1659x2212 · Remidio FOP fundus camera · retinal fundus photograph
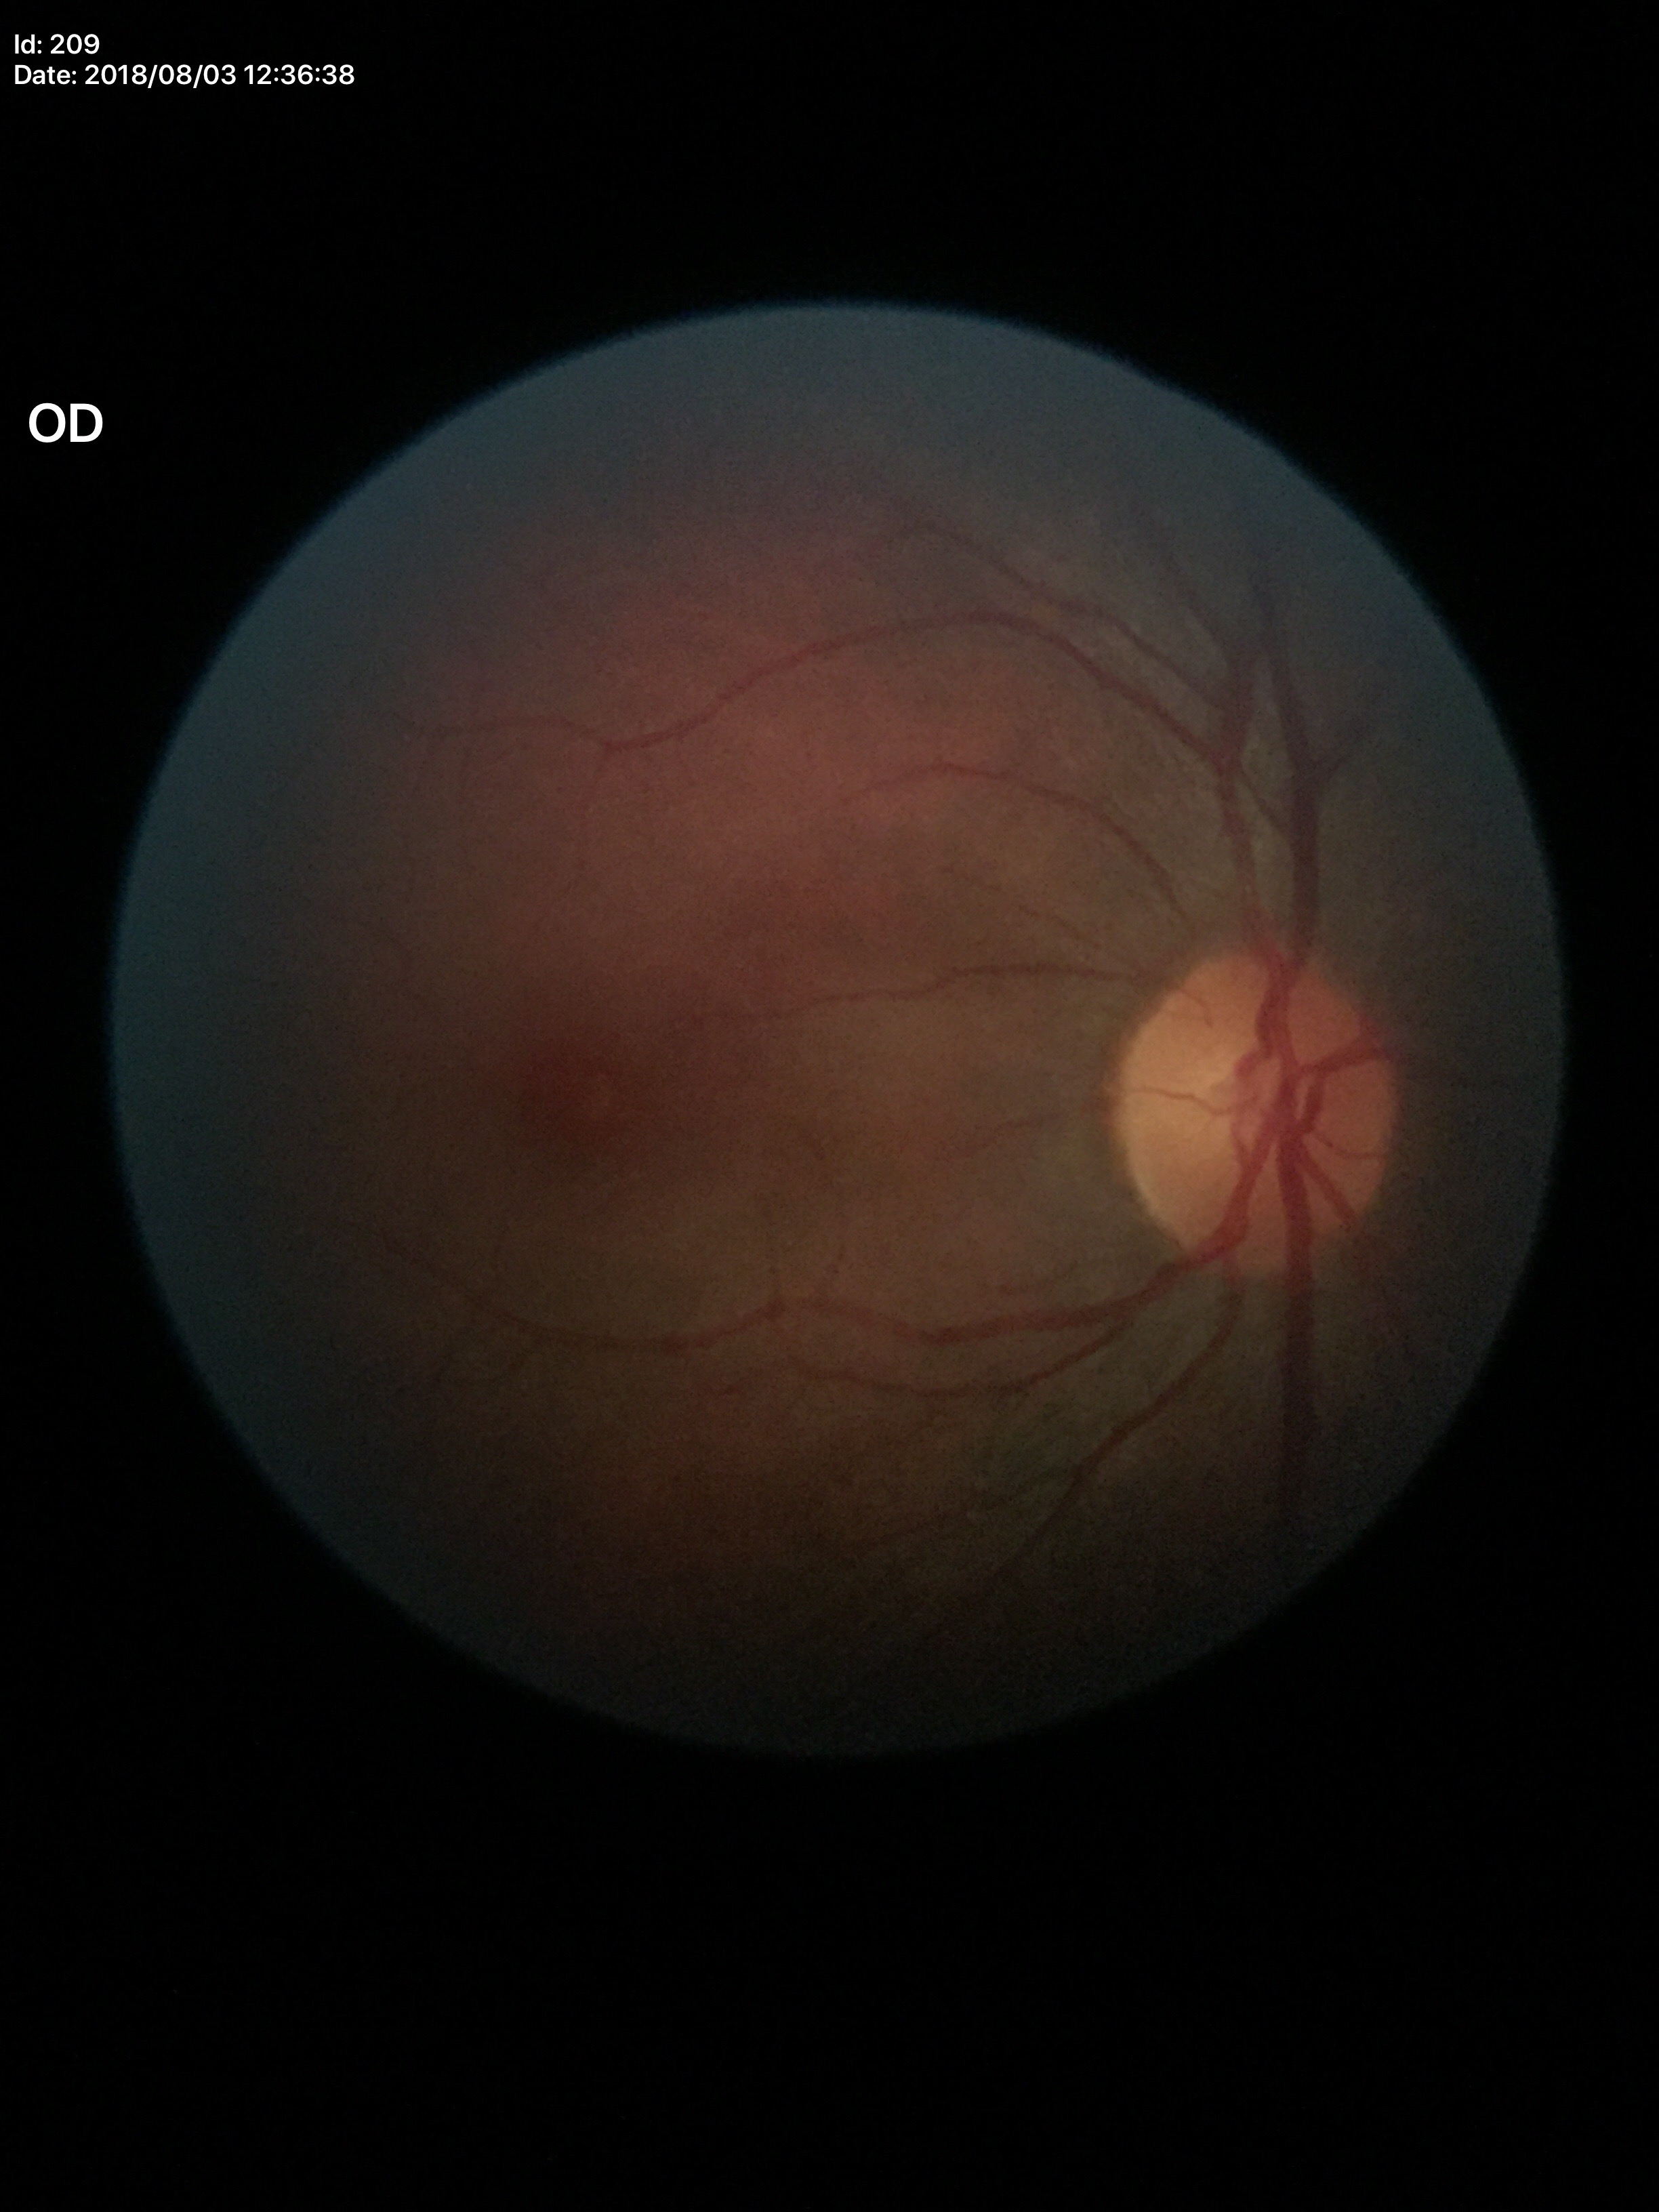 Q: What is the glaucoma assessment?
A: negative (unanimous normal call)
Q: What is the VCDR?
A: 0.43
Q: Area CDR?
A: 0.20